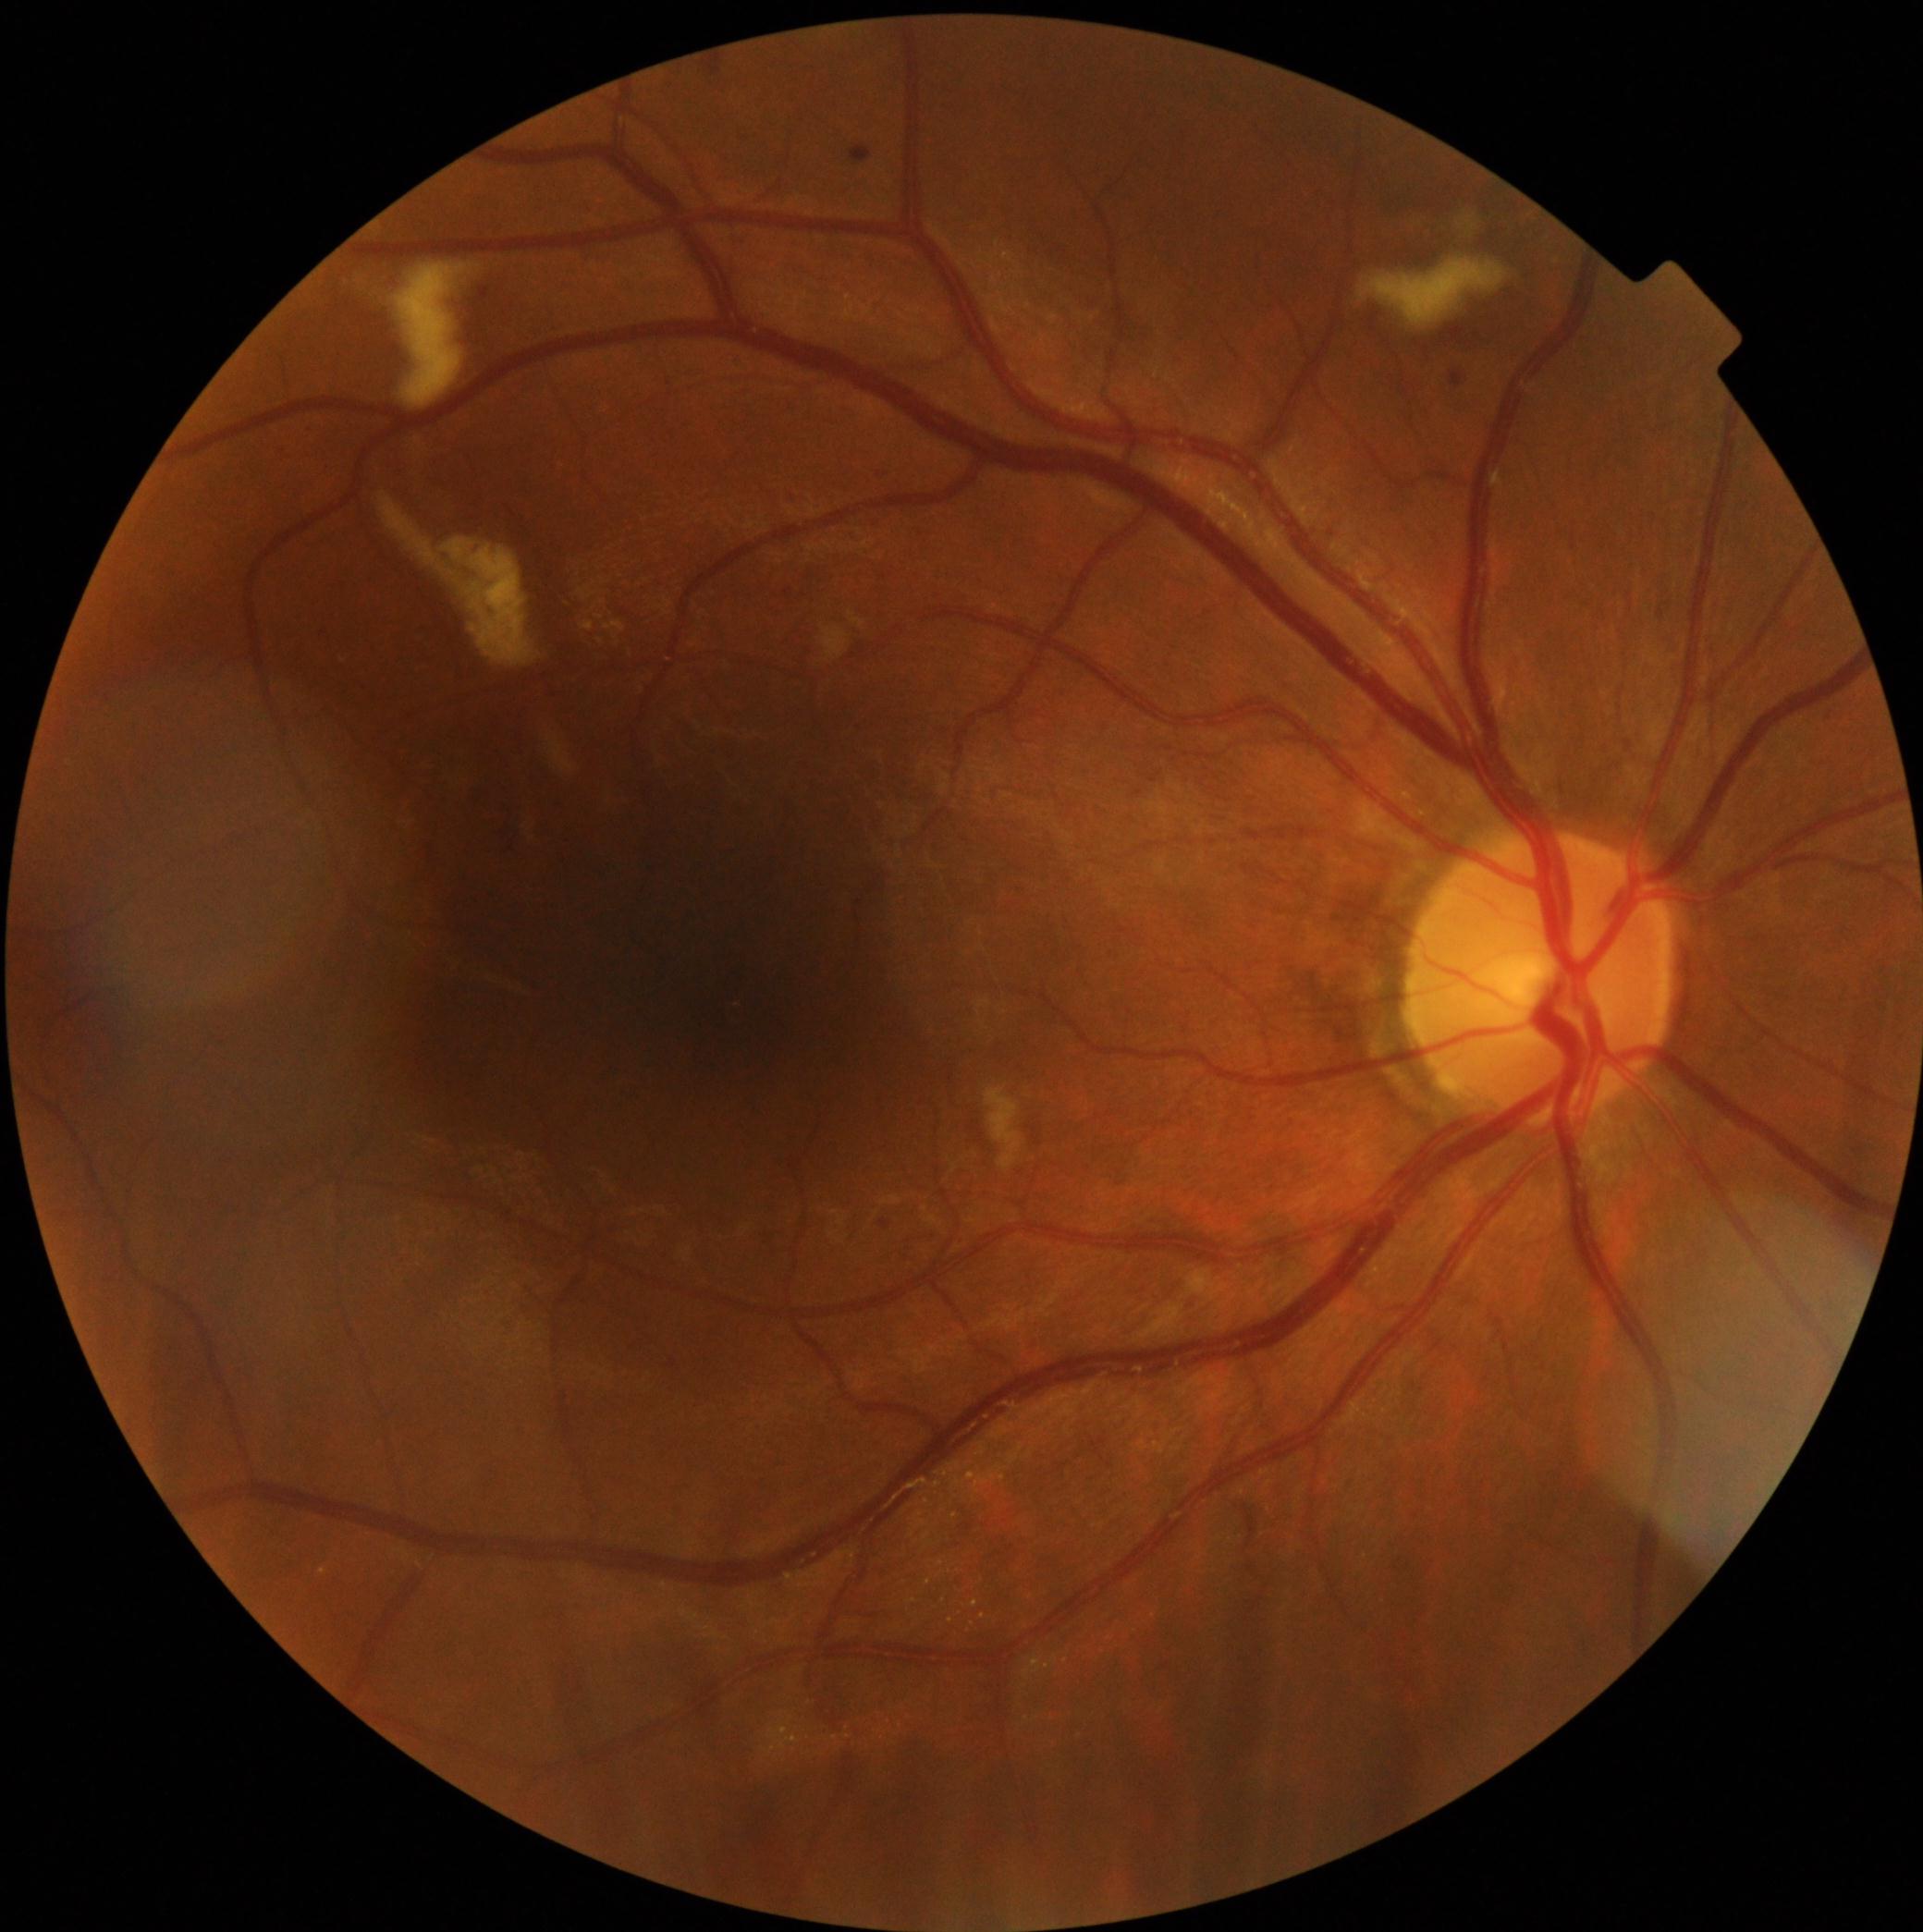
retinopathy grade@2.